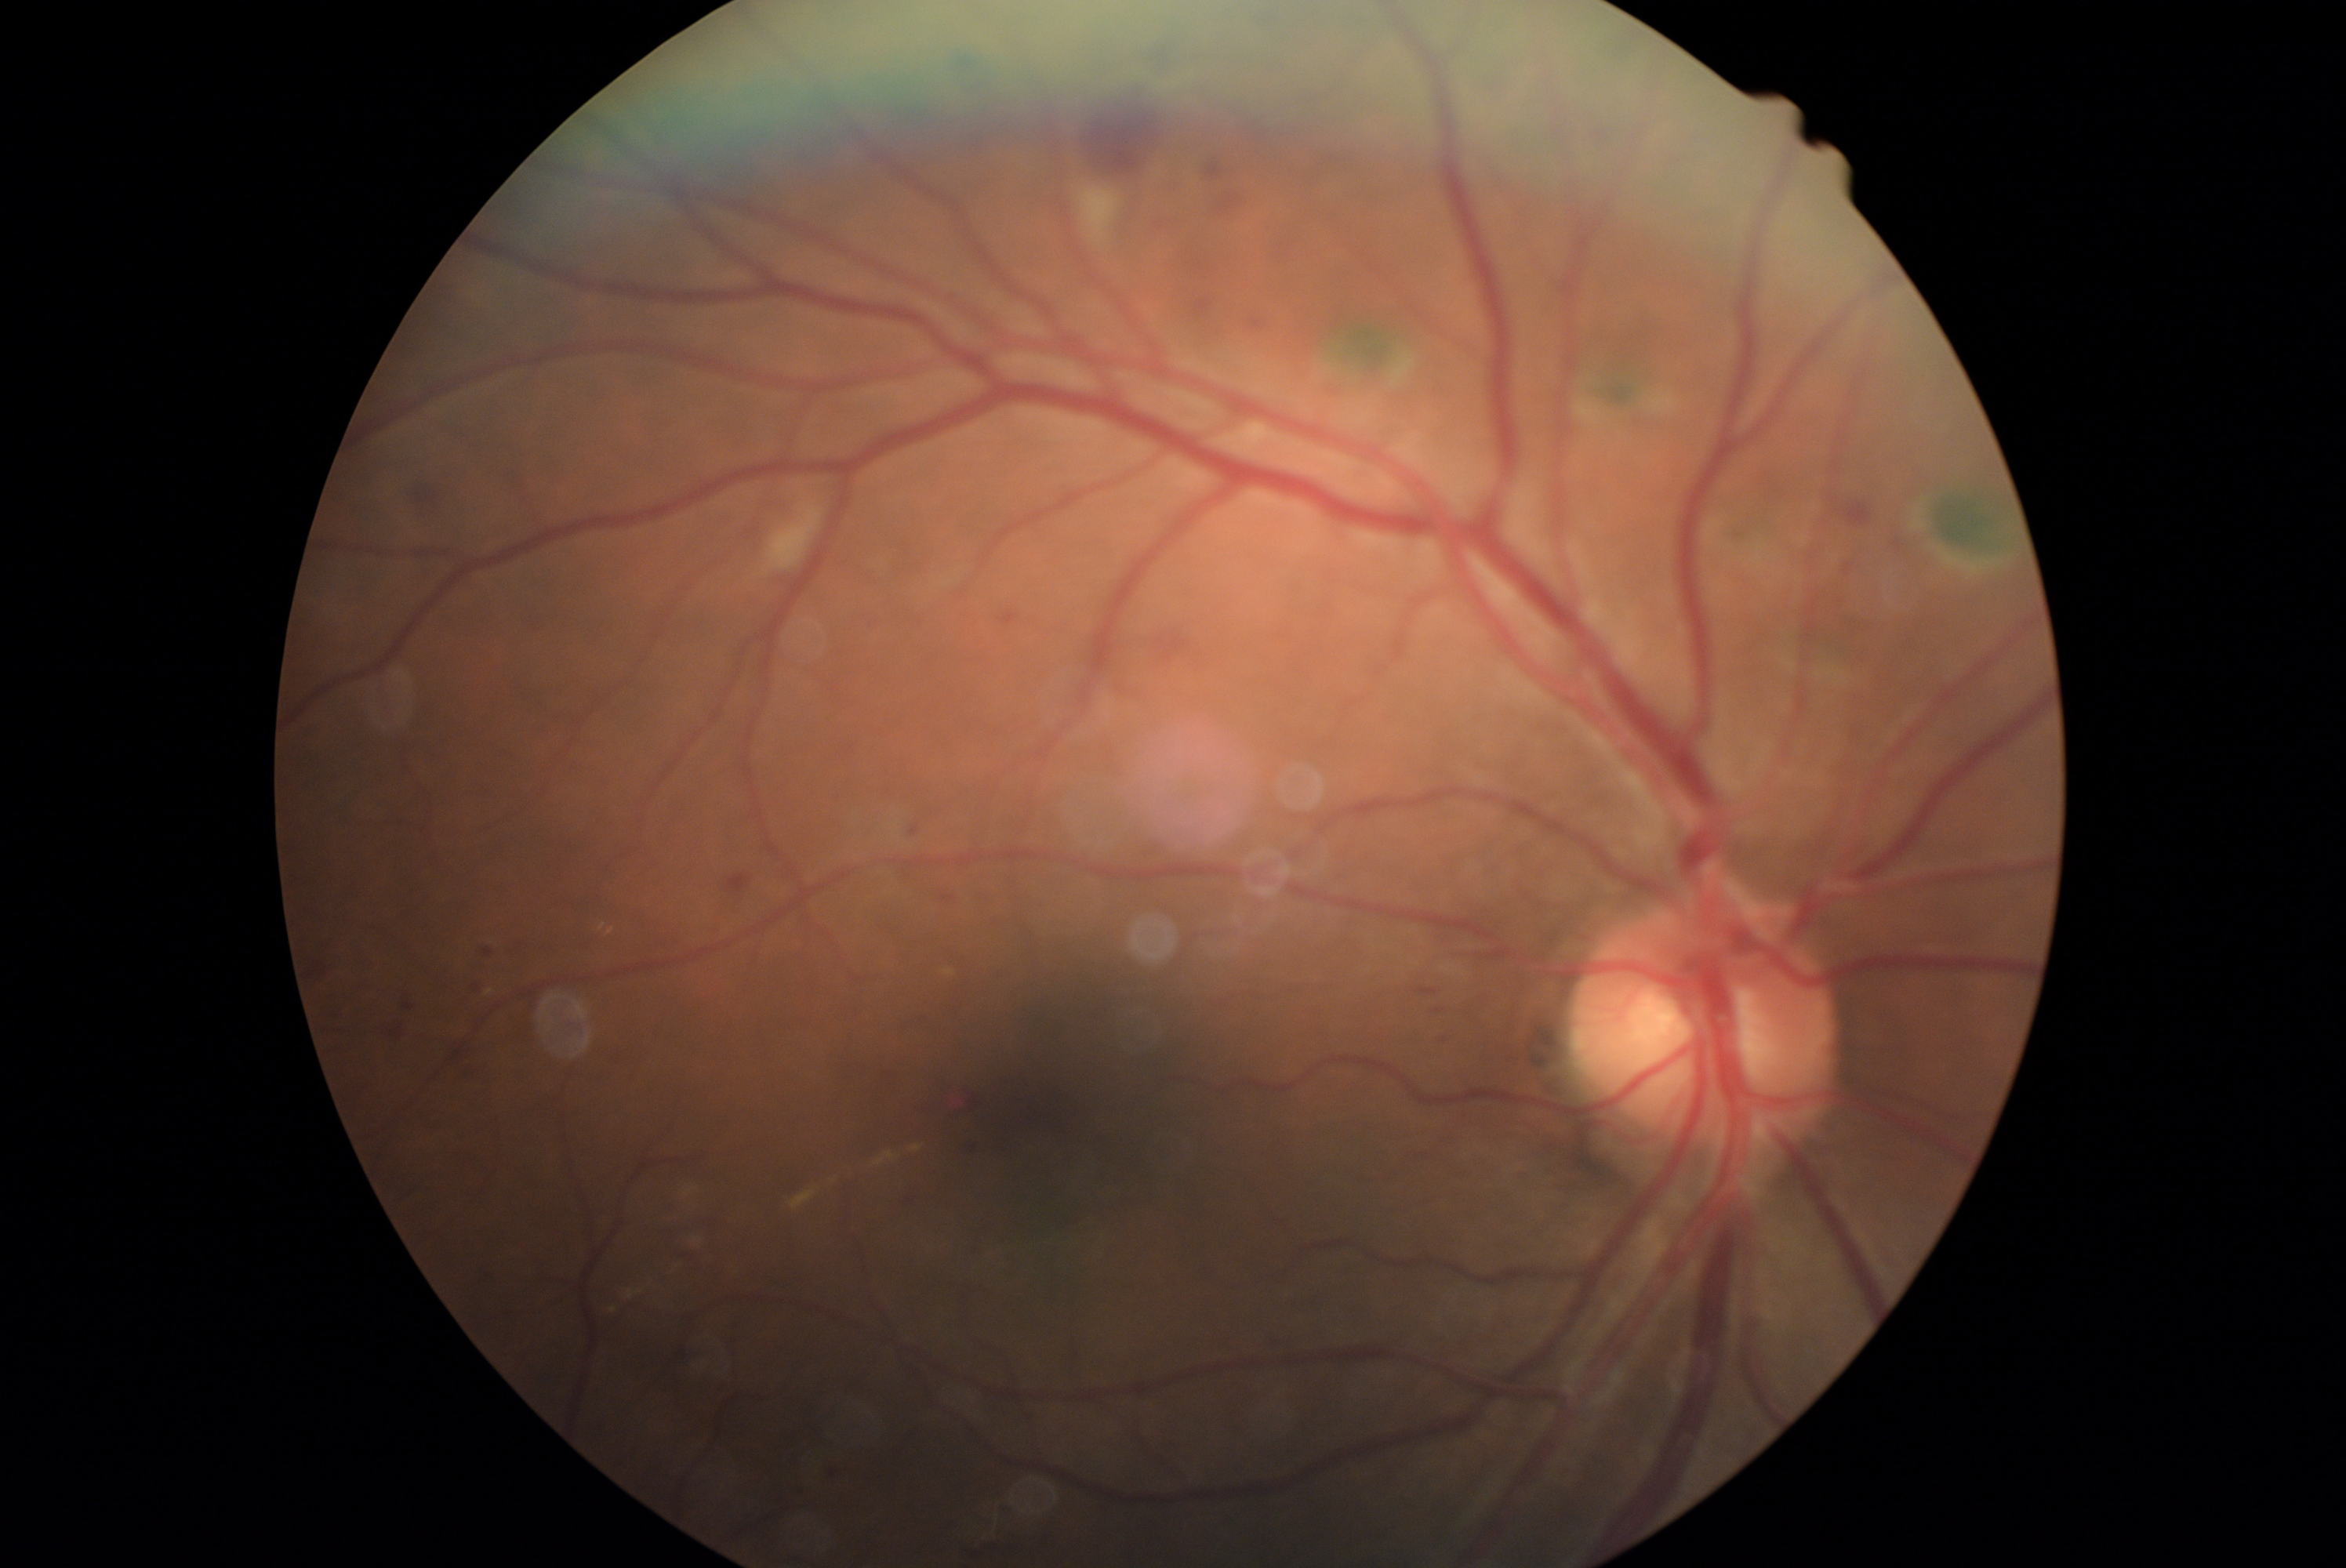
DR stage is grade 2 (moderate NPDR) — more than just microaneurysms but less than severe NPDR.